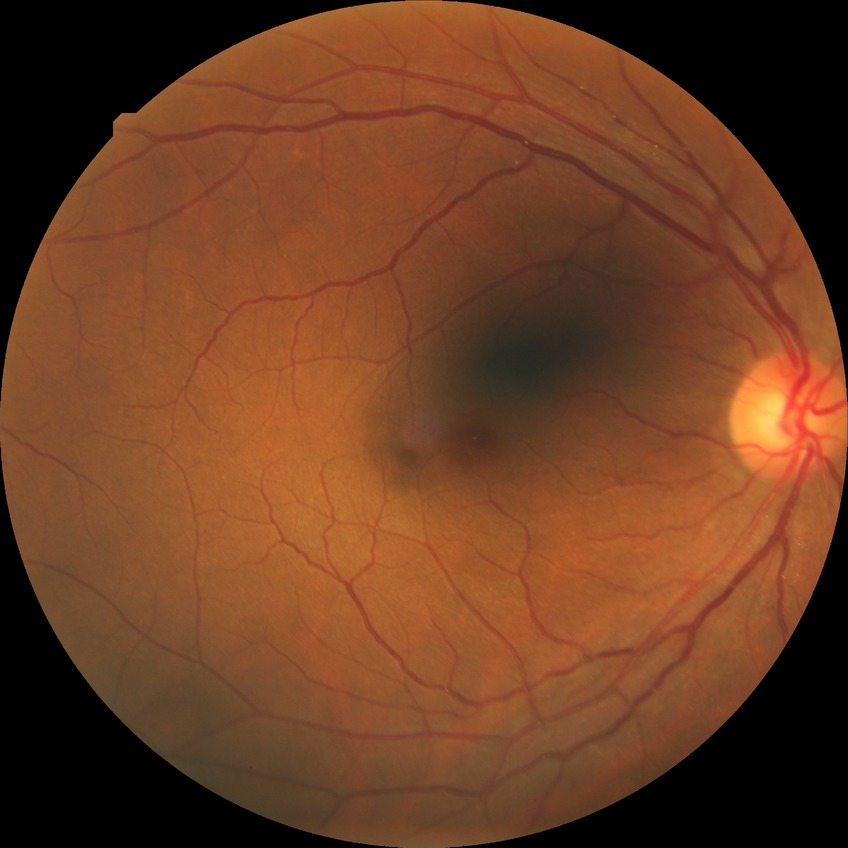
modified Davis grading: no diabetic retinopathy.